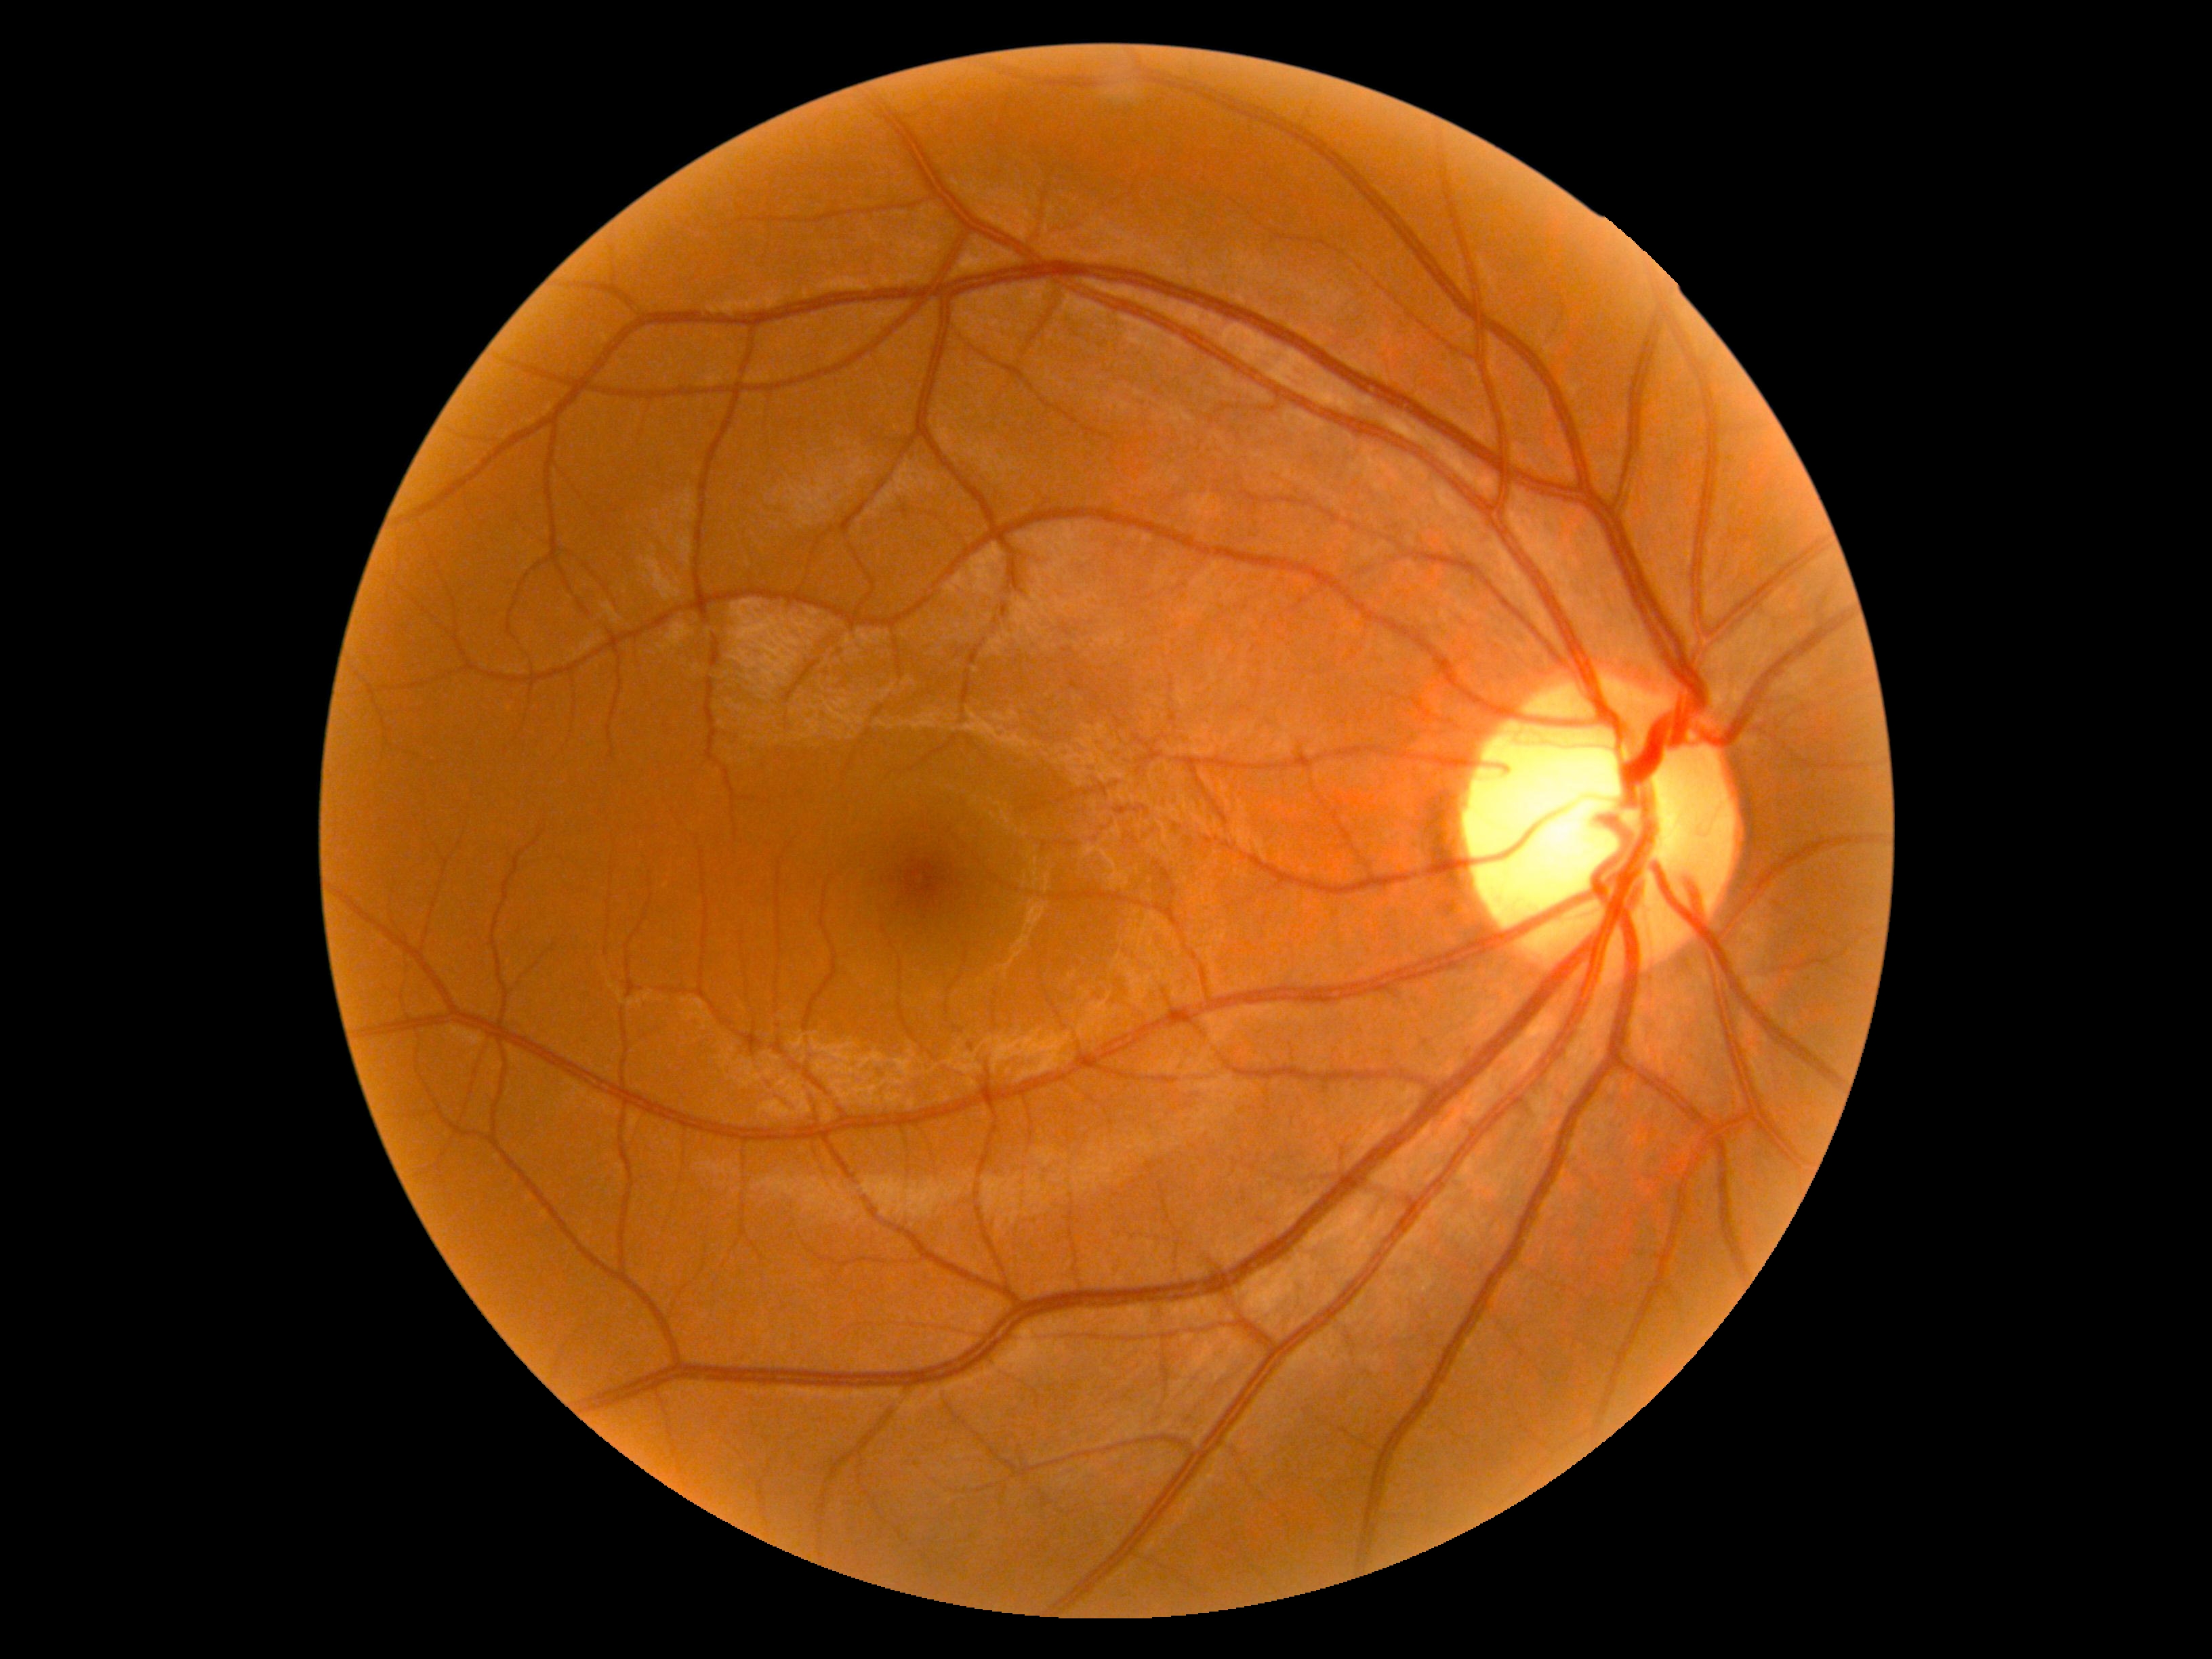
DR impression=no apparent DR; retinopathy grade=no apparent retinopathy (0).